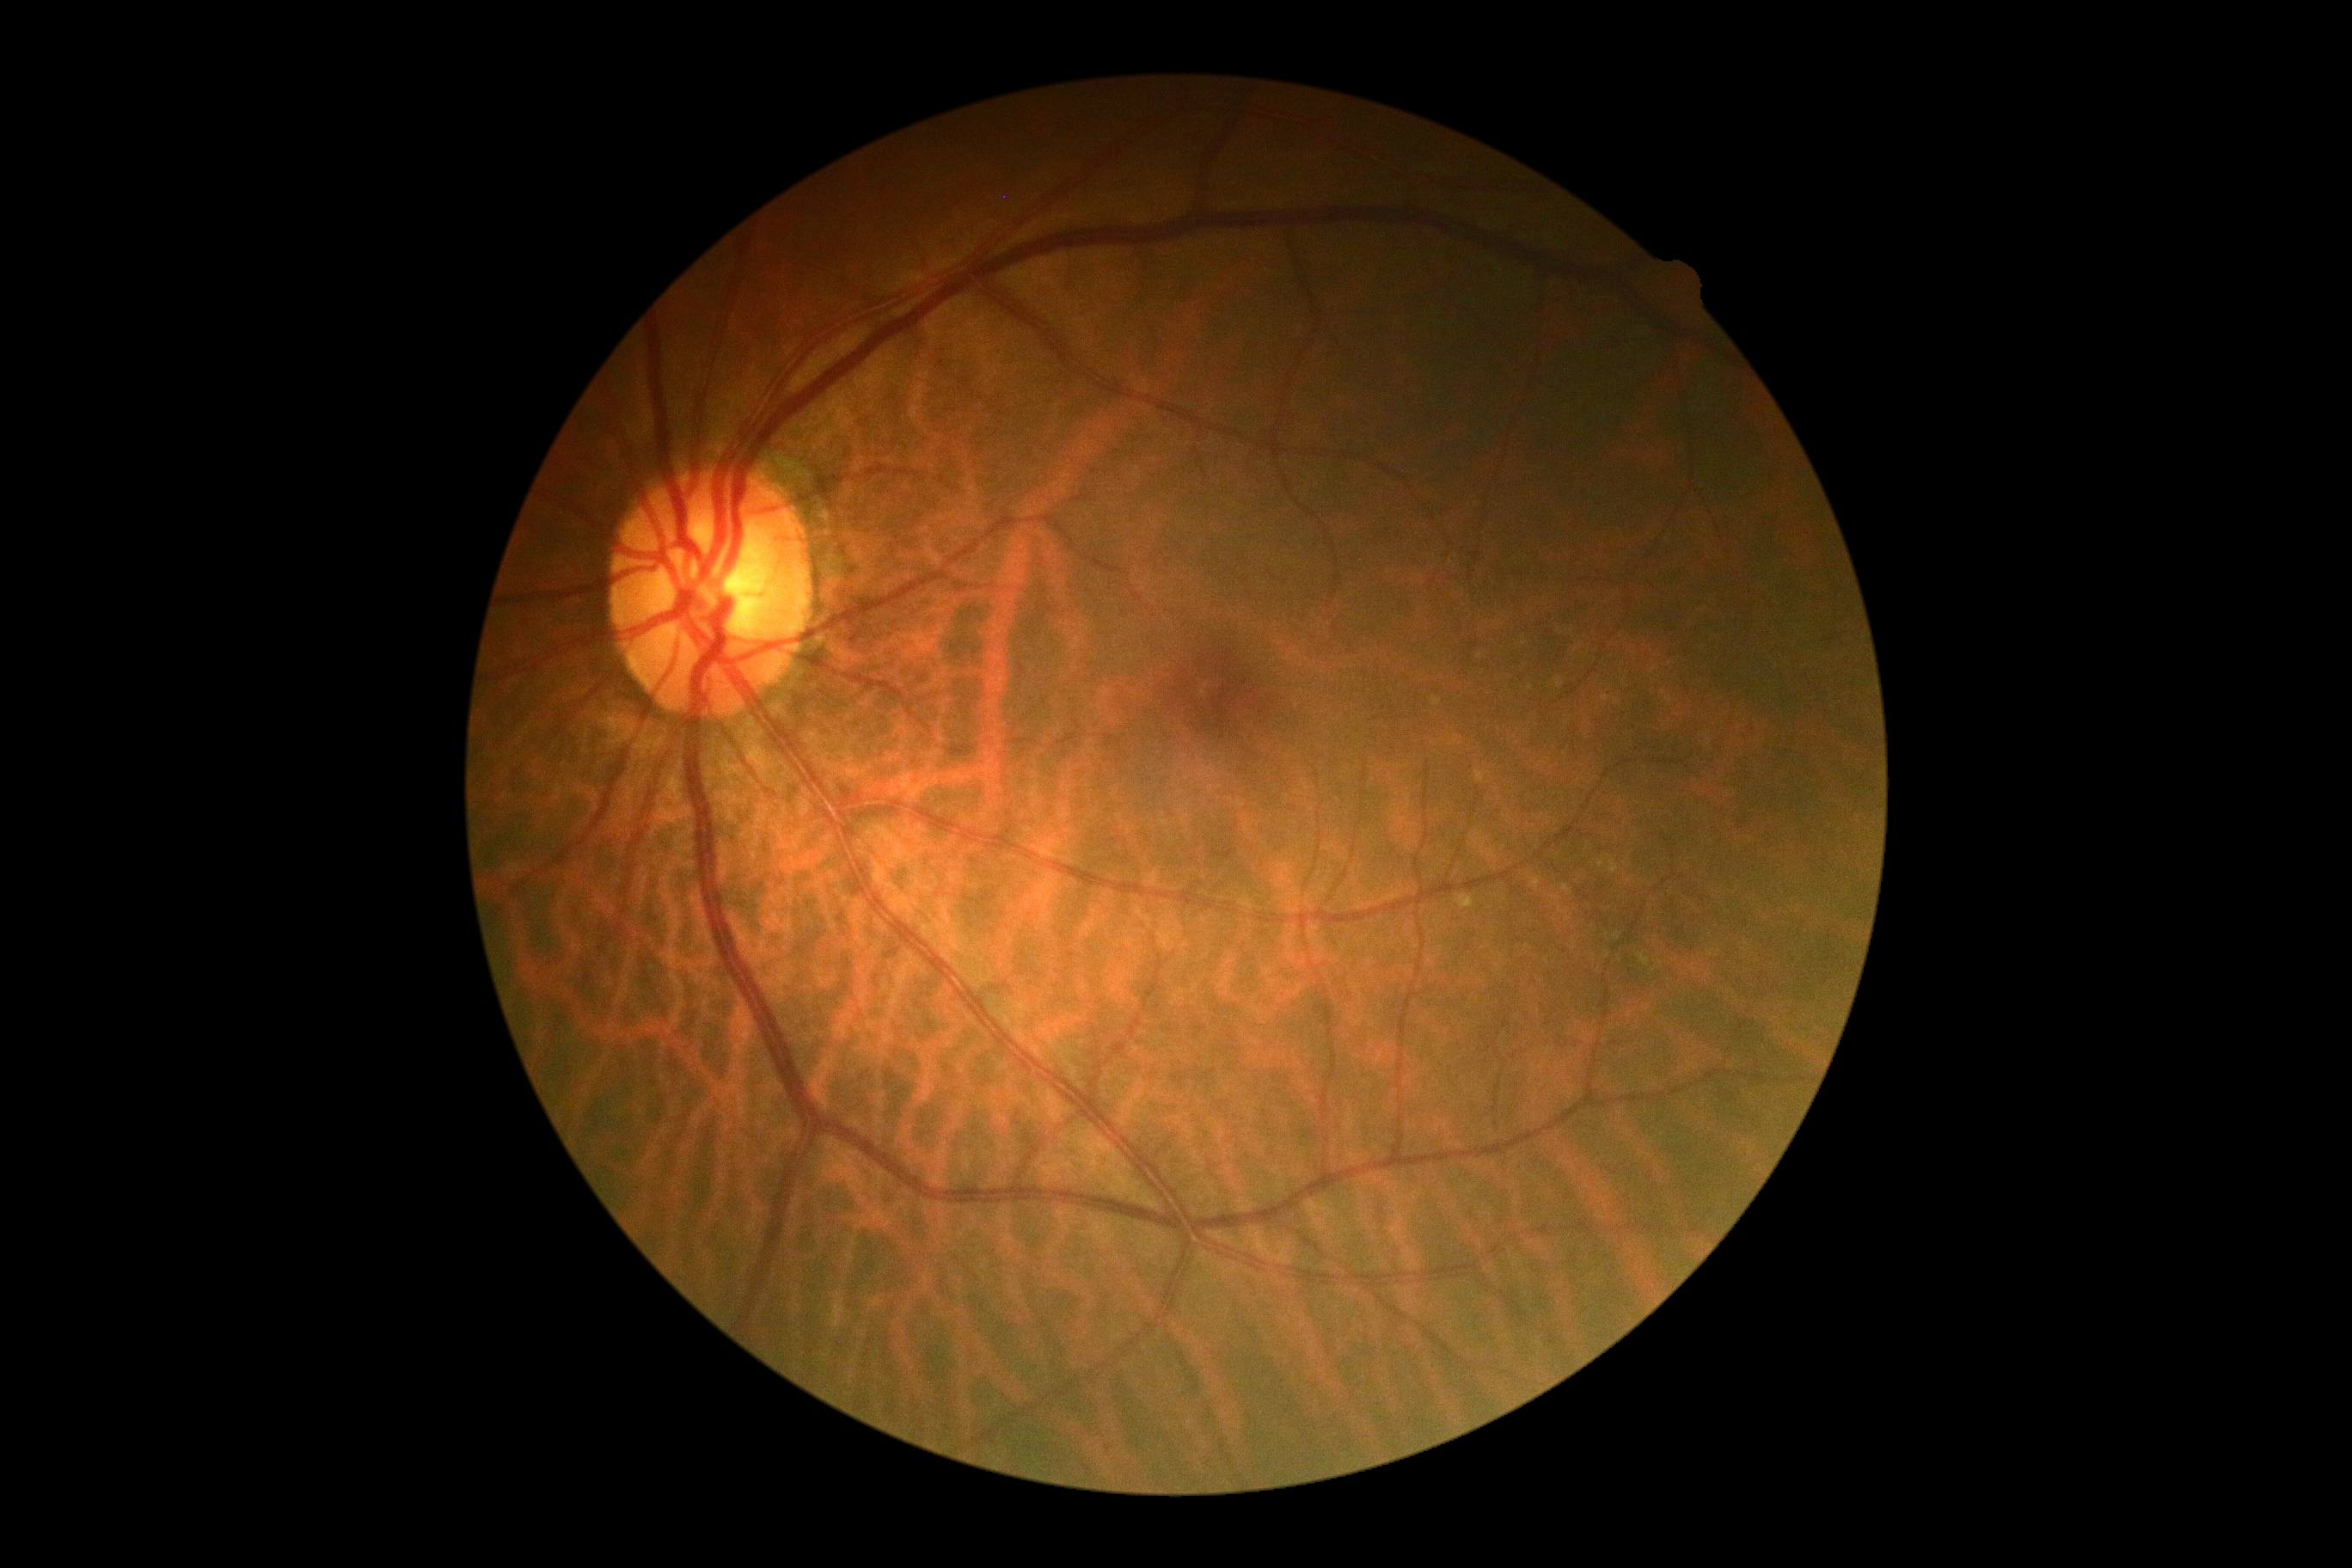
DR is 0/4.